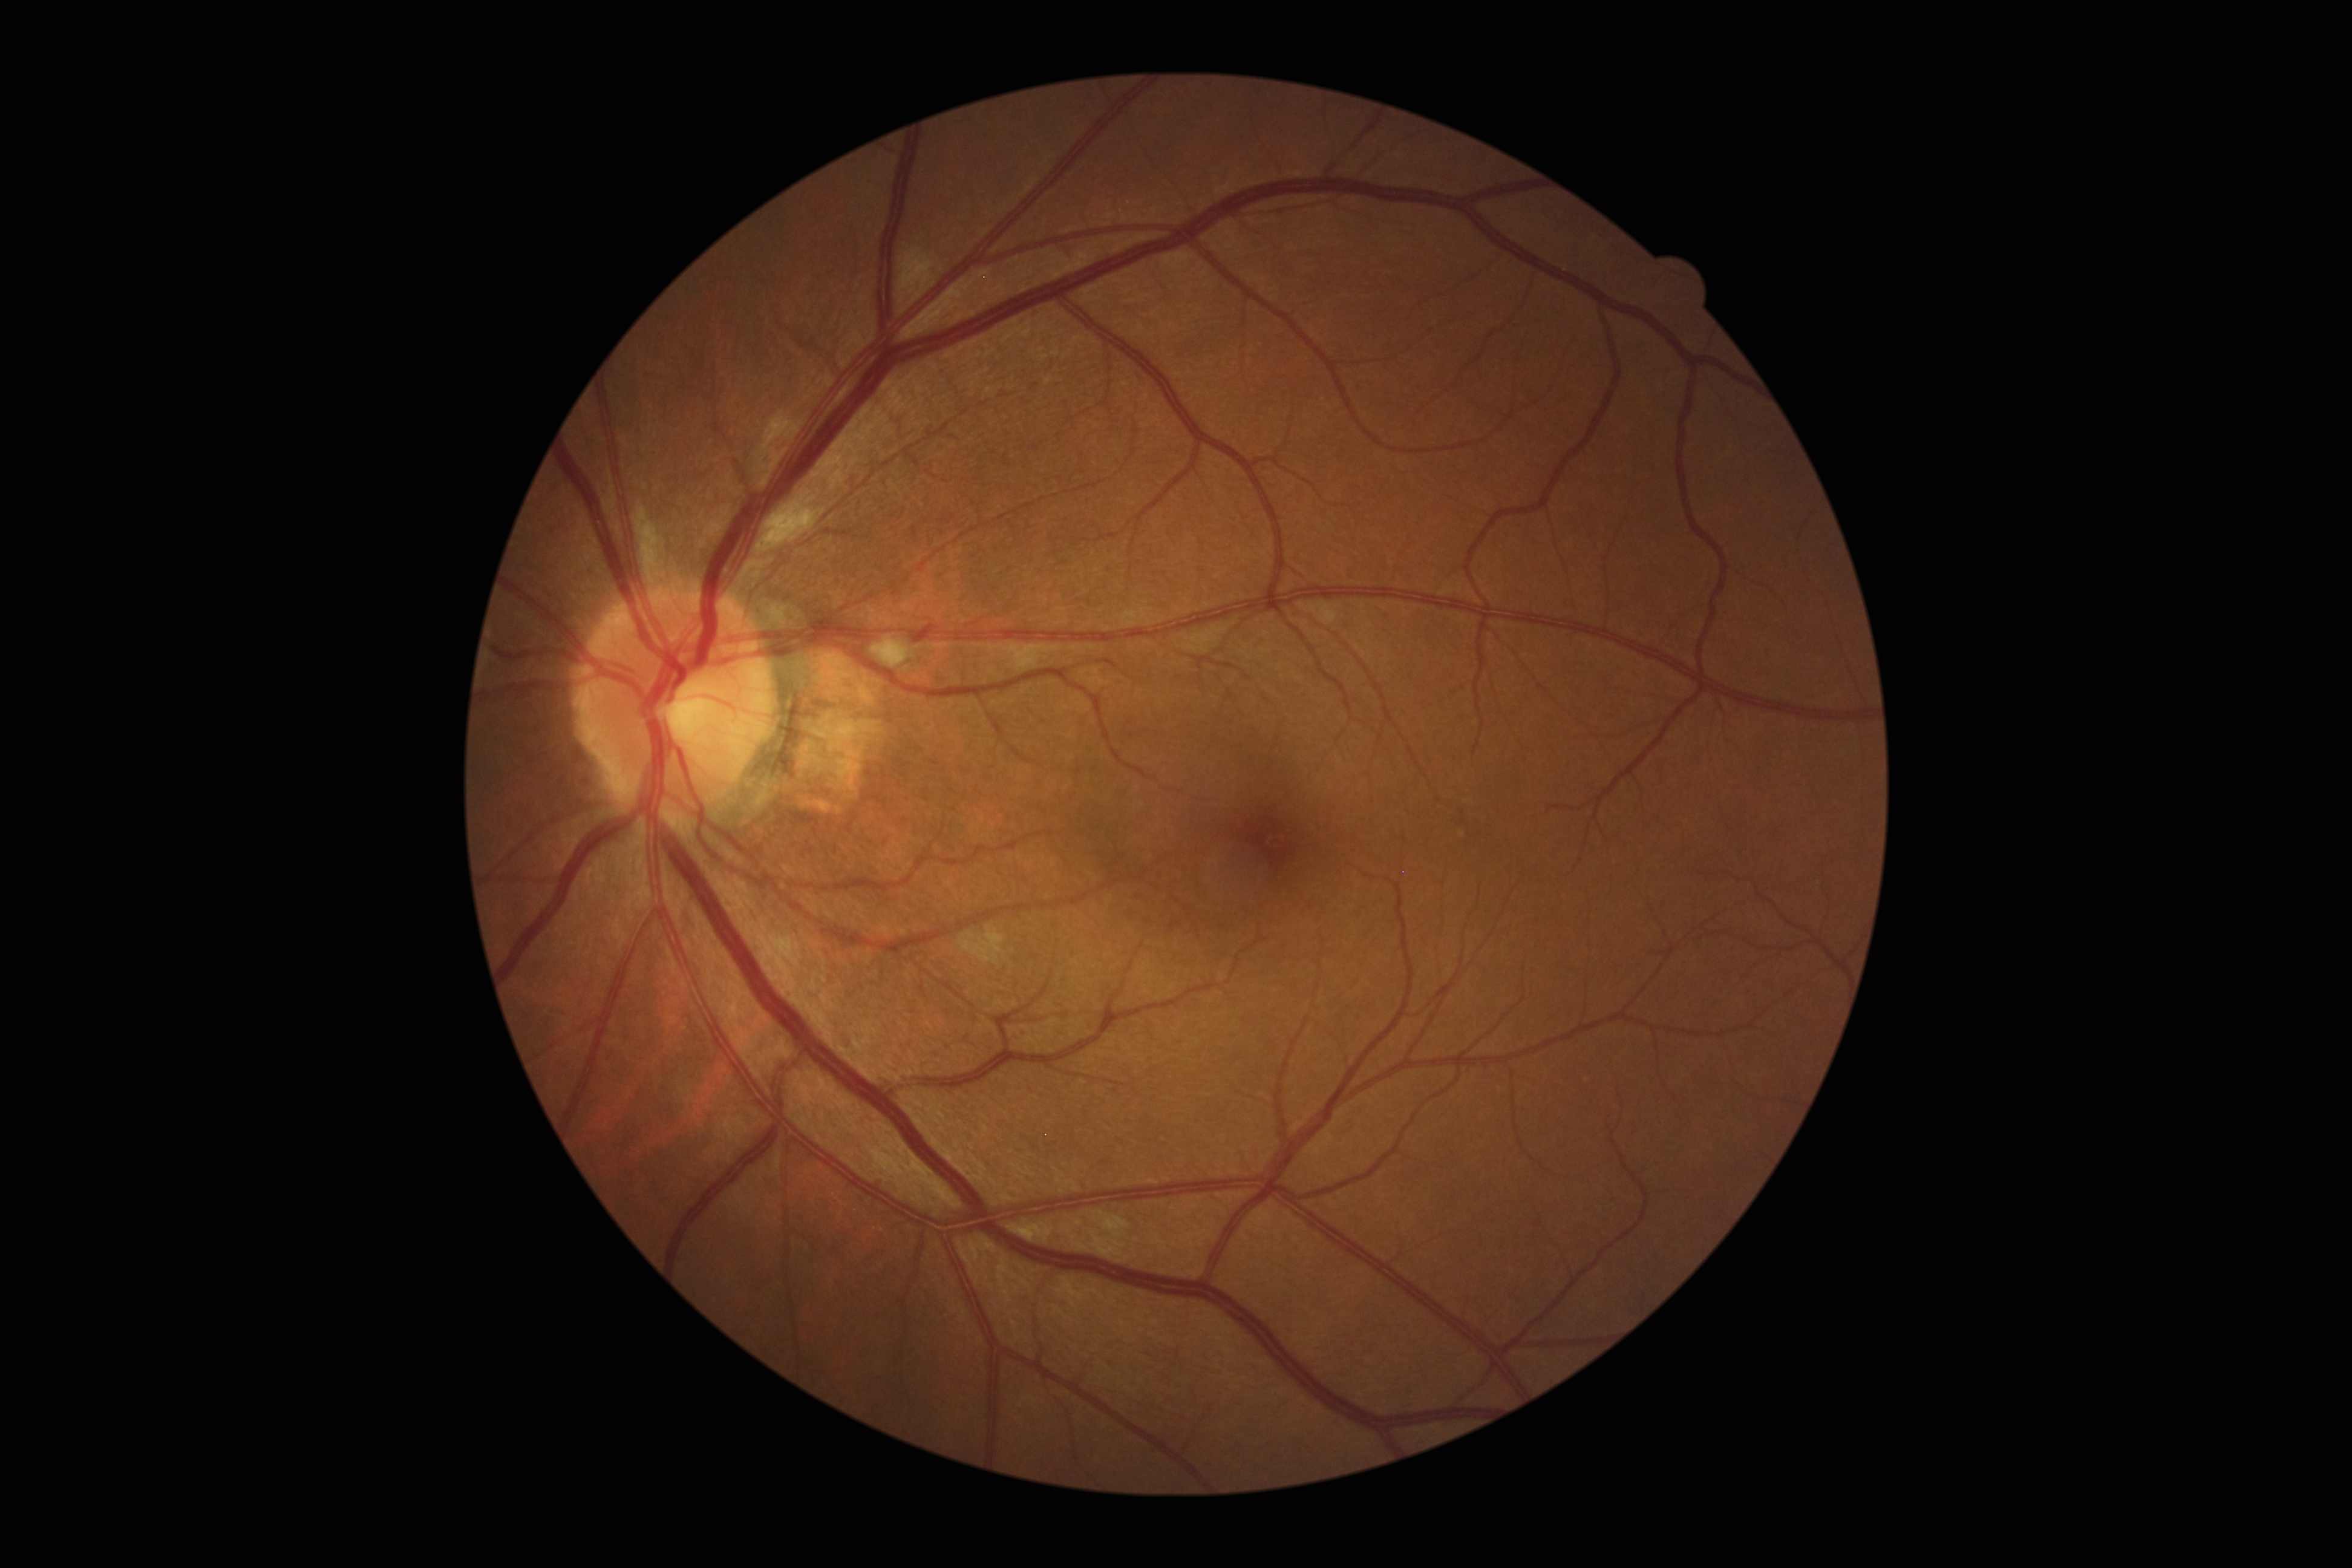 Annotations:
- DR severity — 2/4